Diabetic retinopathy graded by the modified Davis classification, NIDEK AFC-230, 848x848px, fundus photo.
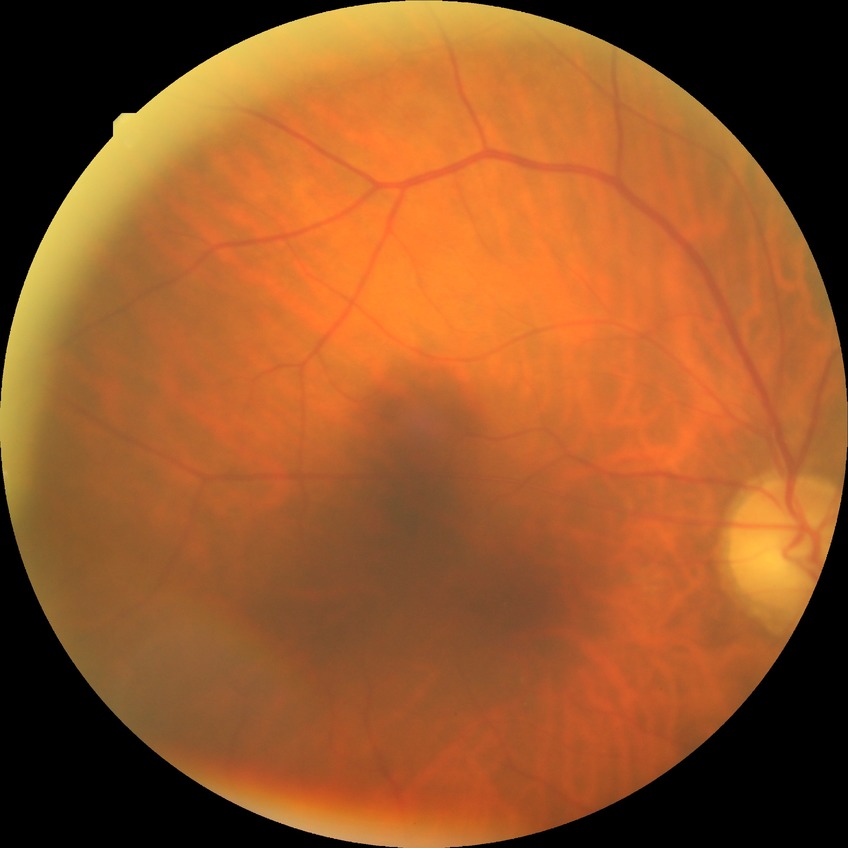
diabetic retinopathy (DR) = NDR (no diabetic retinopathy).